Acquired with a NIDEK AFC-230. CFP:
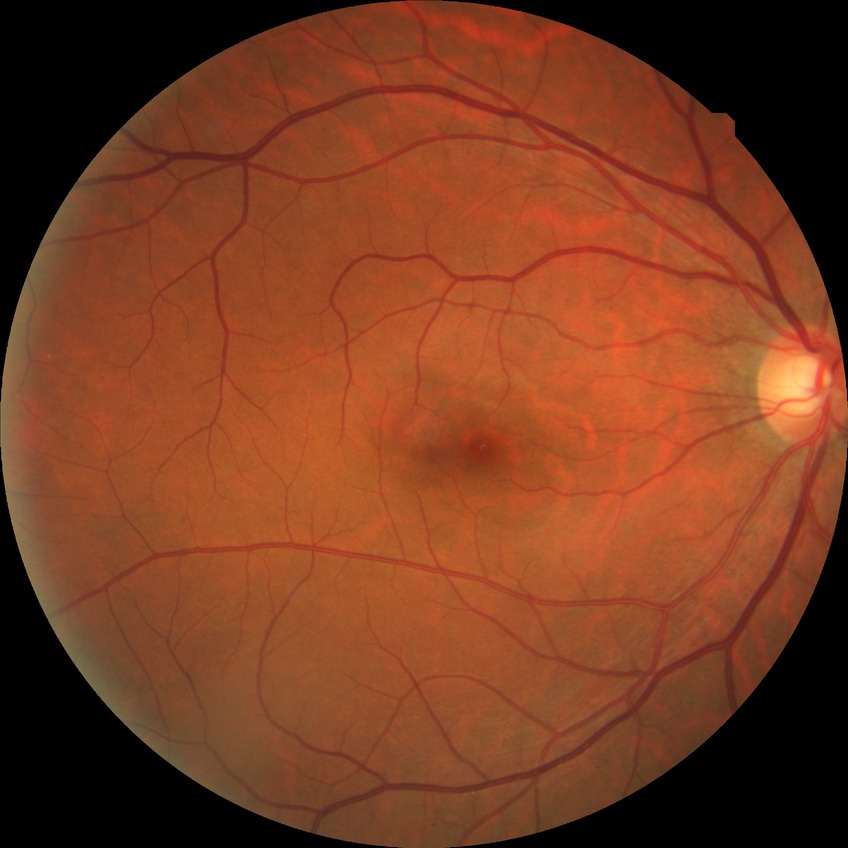

Davis stage: NDR.